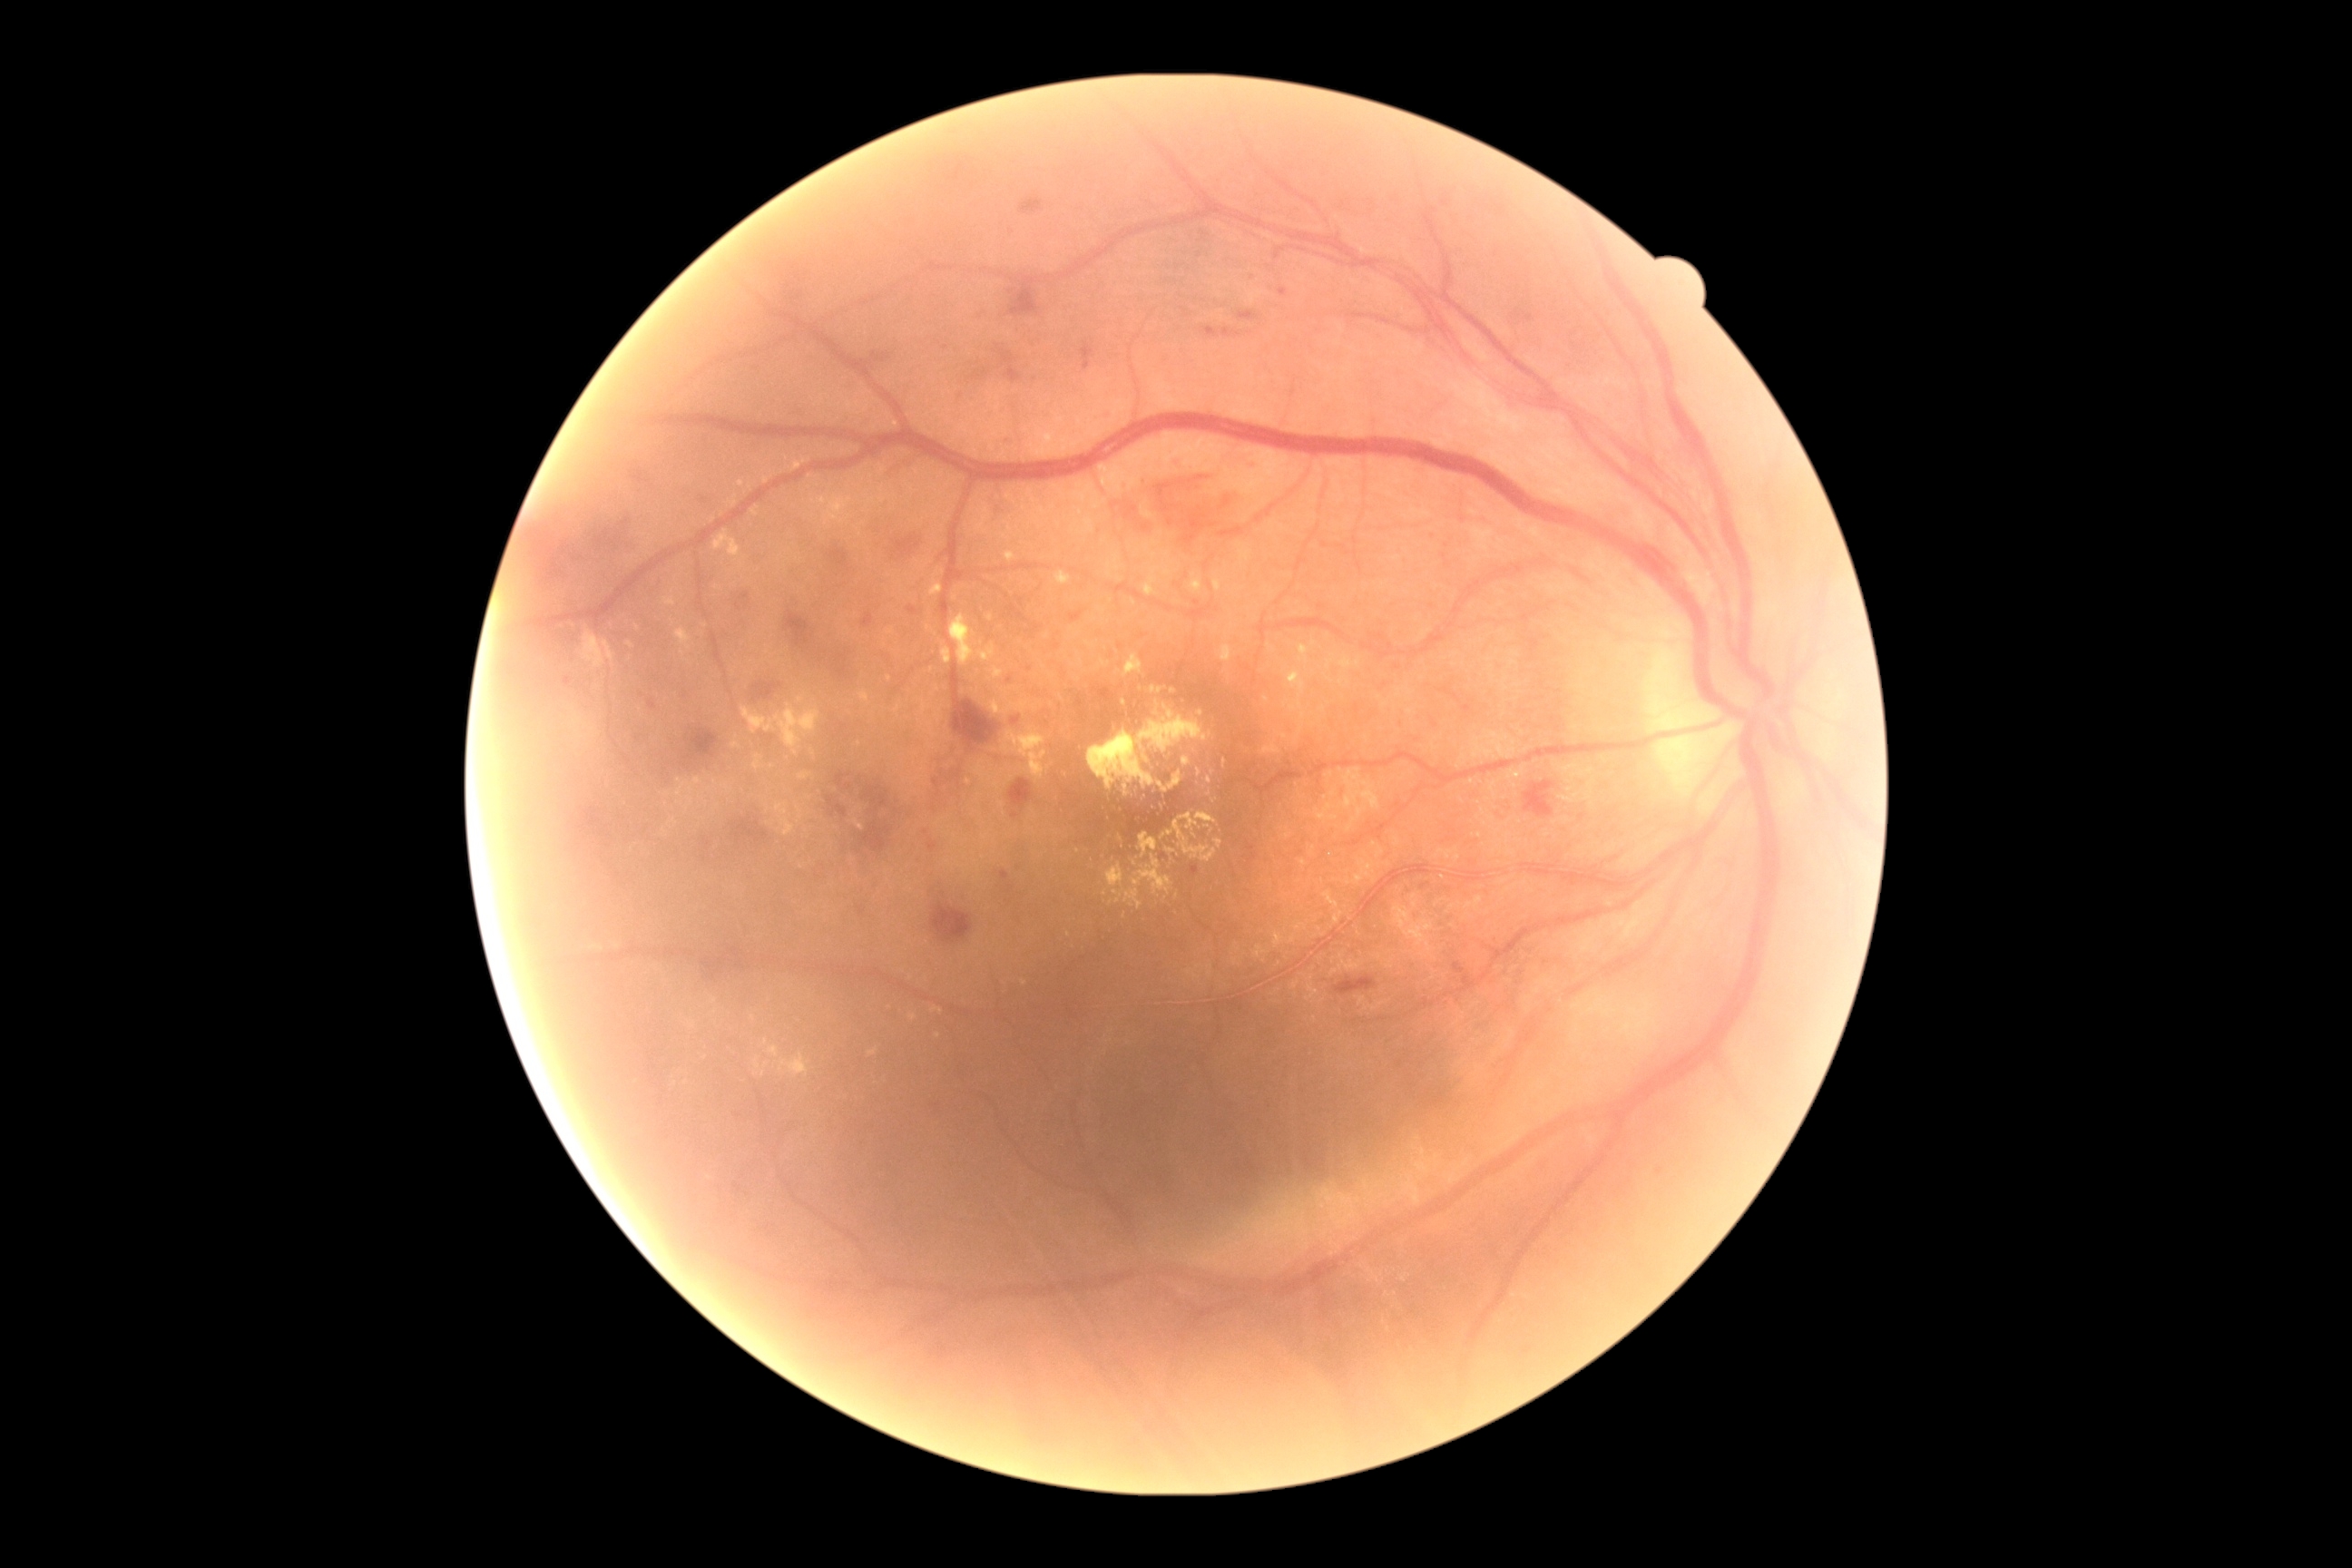 Retinopathy is moderate NPDR (grade 2)
A subset of detected lesions:
• hard exudates (continued): (663, 596, 676, 607) | (1106, 863, 1124, 888) | (676, 783, 689, 798) | (1006, 701, 1028, 712) | (754, 756, 761, 770) | (779, 1054, 810, 1077) | (1086, 643, 1095, 649) | (1132, 856, 1173, 896) | (1152, 687, 1162, 694)
• Hard exudates (small, approximate centers) near [687,1084] | [630,645] | [1118,901] | [813,753] | [934,696] | [1136,864] | [1269,647] | [1173,691] | [718,588]